2352x1568.
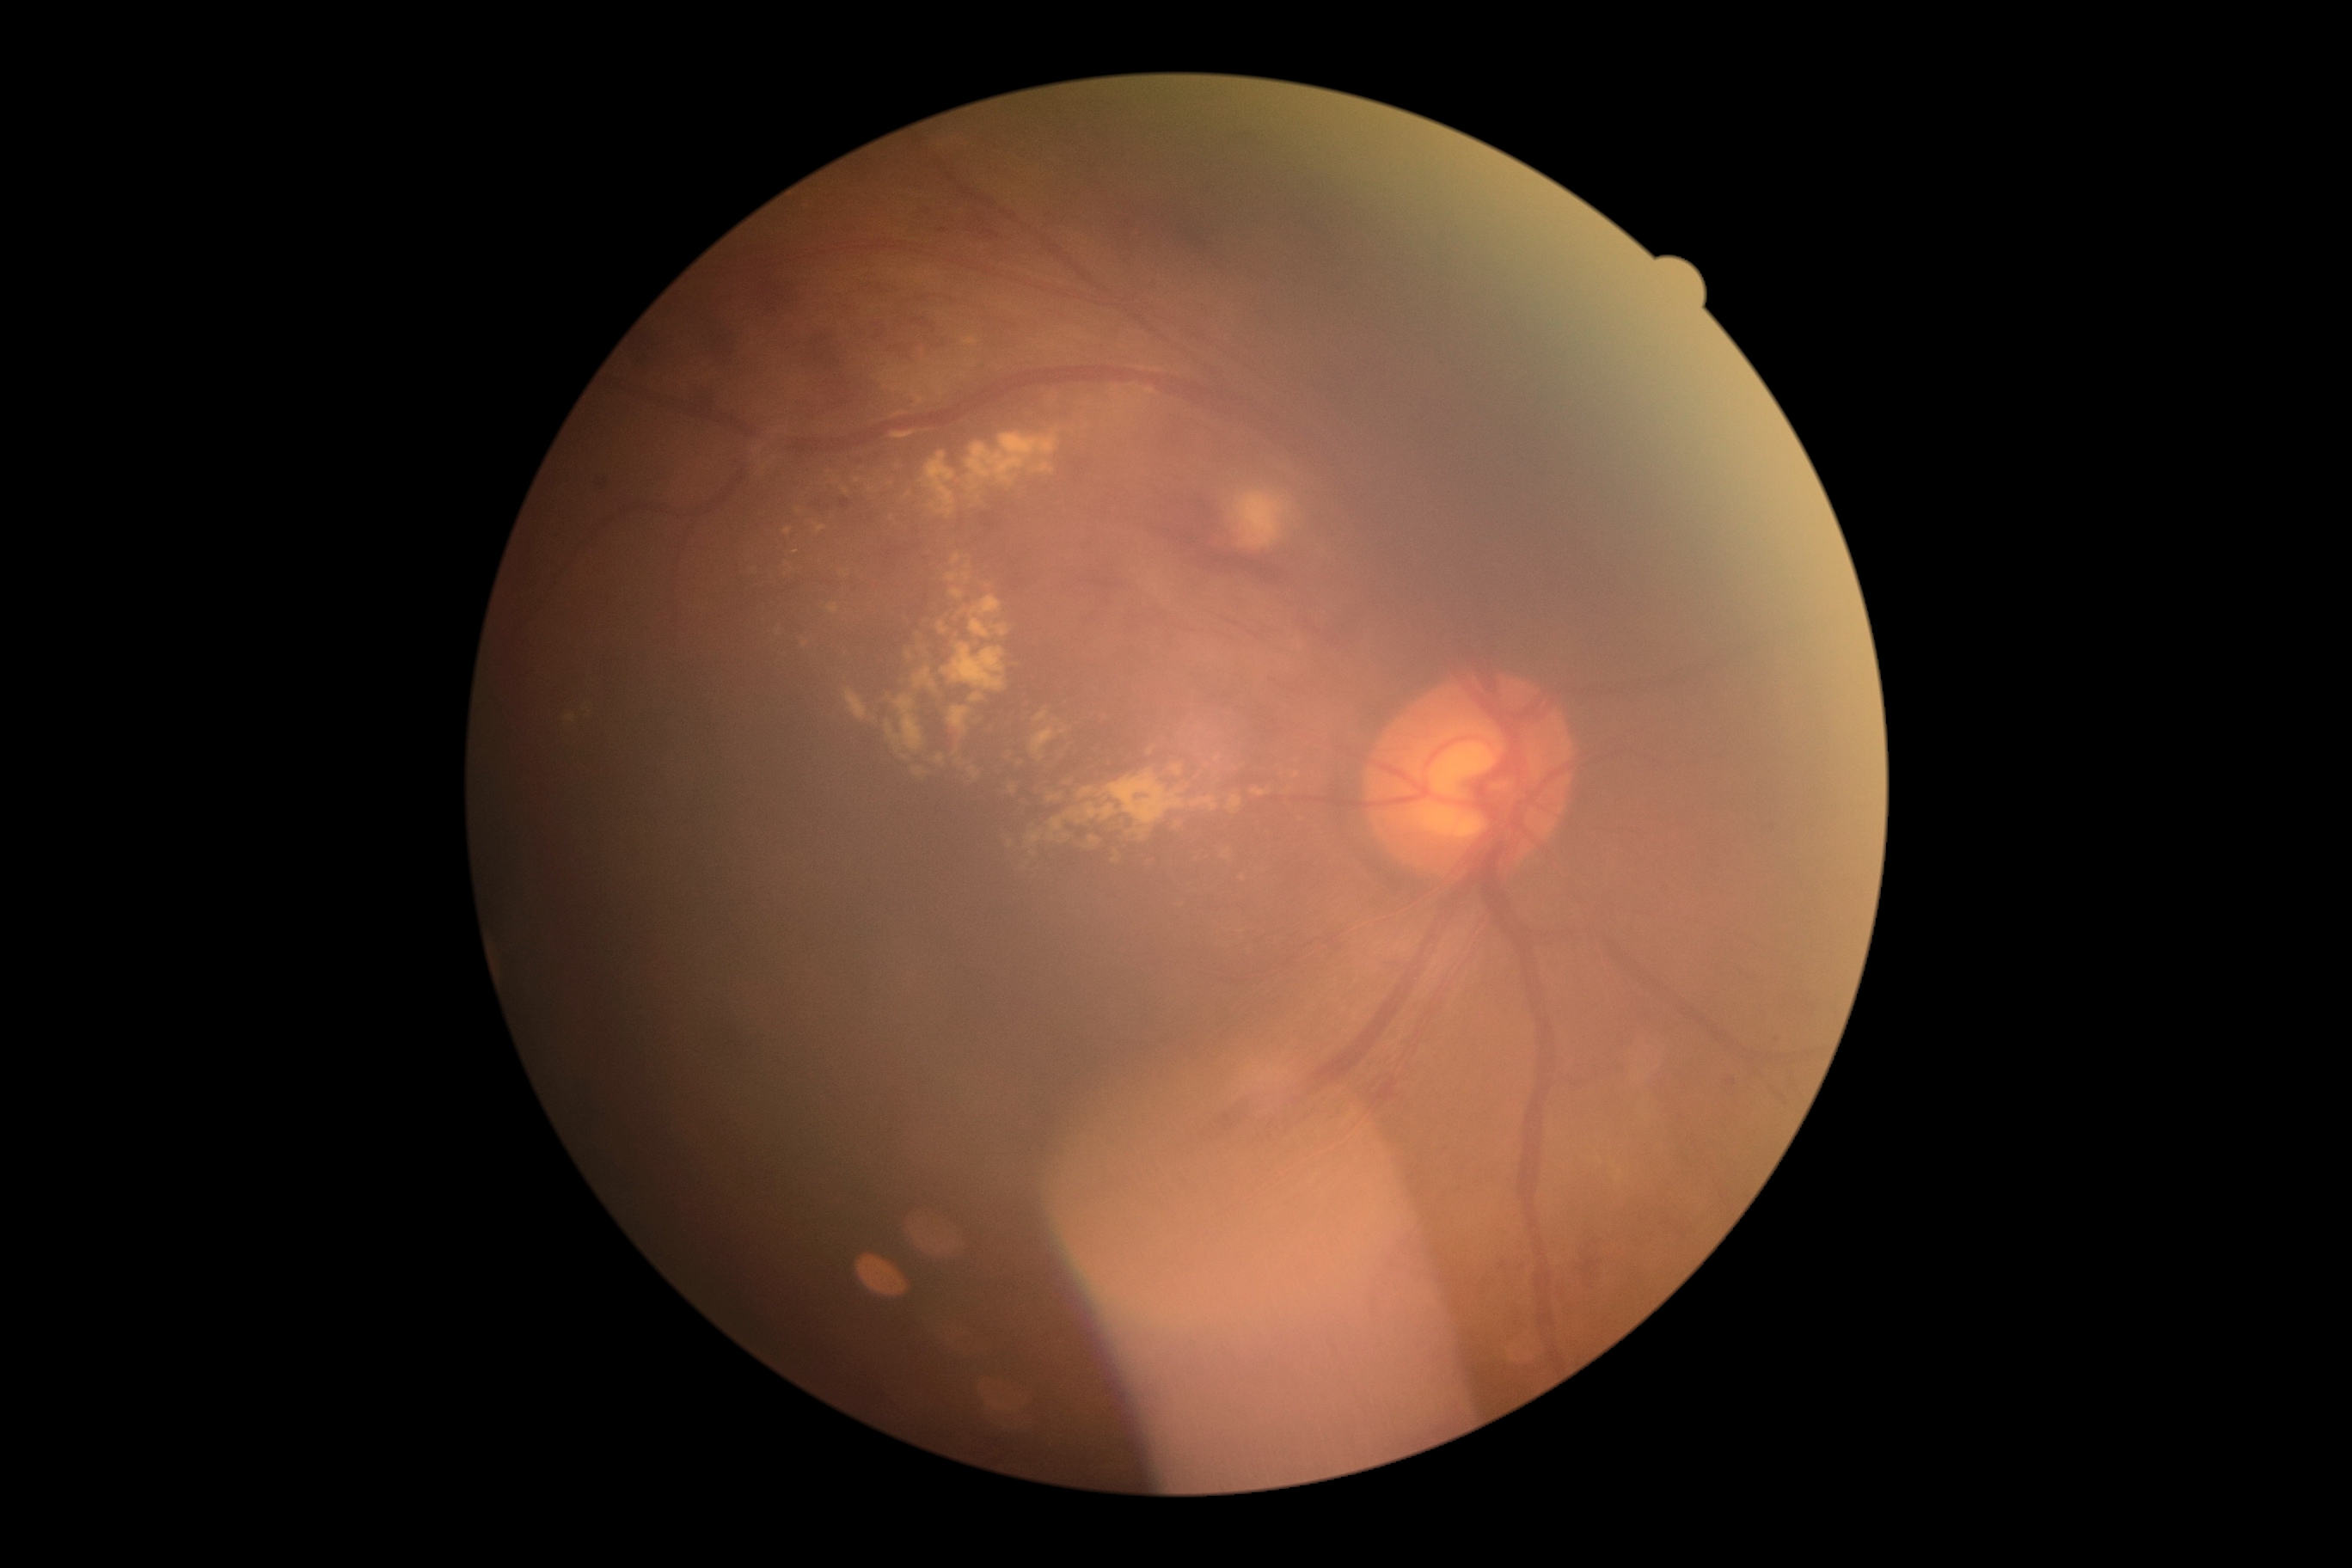 DR grade: moderate NPDR (2) — more than just microaneurysms but less than severe NPDR.